Wide-field contact fundus photograph of an infant. 640 x 480 pixels. Camera: Clarity RetCam 3 (130° FOV):
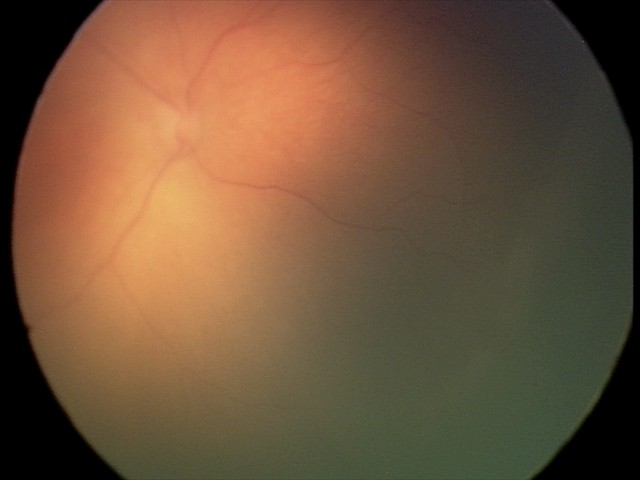 Finding: retinopathy of prematurity stage 1
plus disease: absent